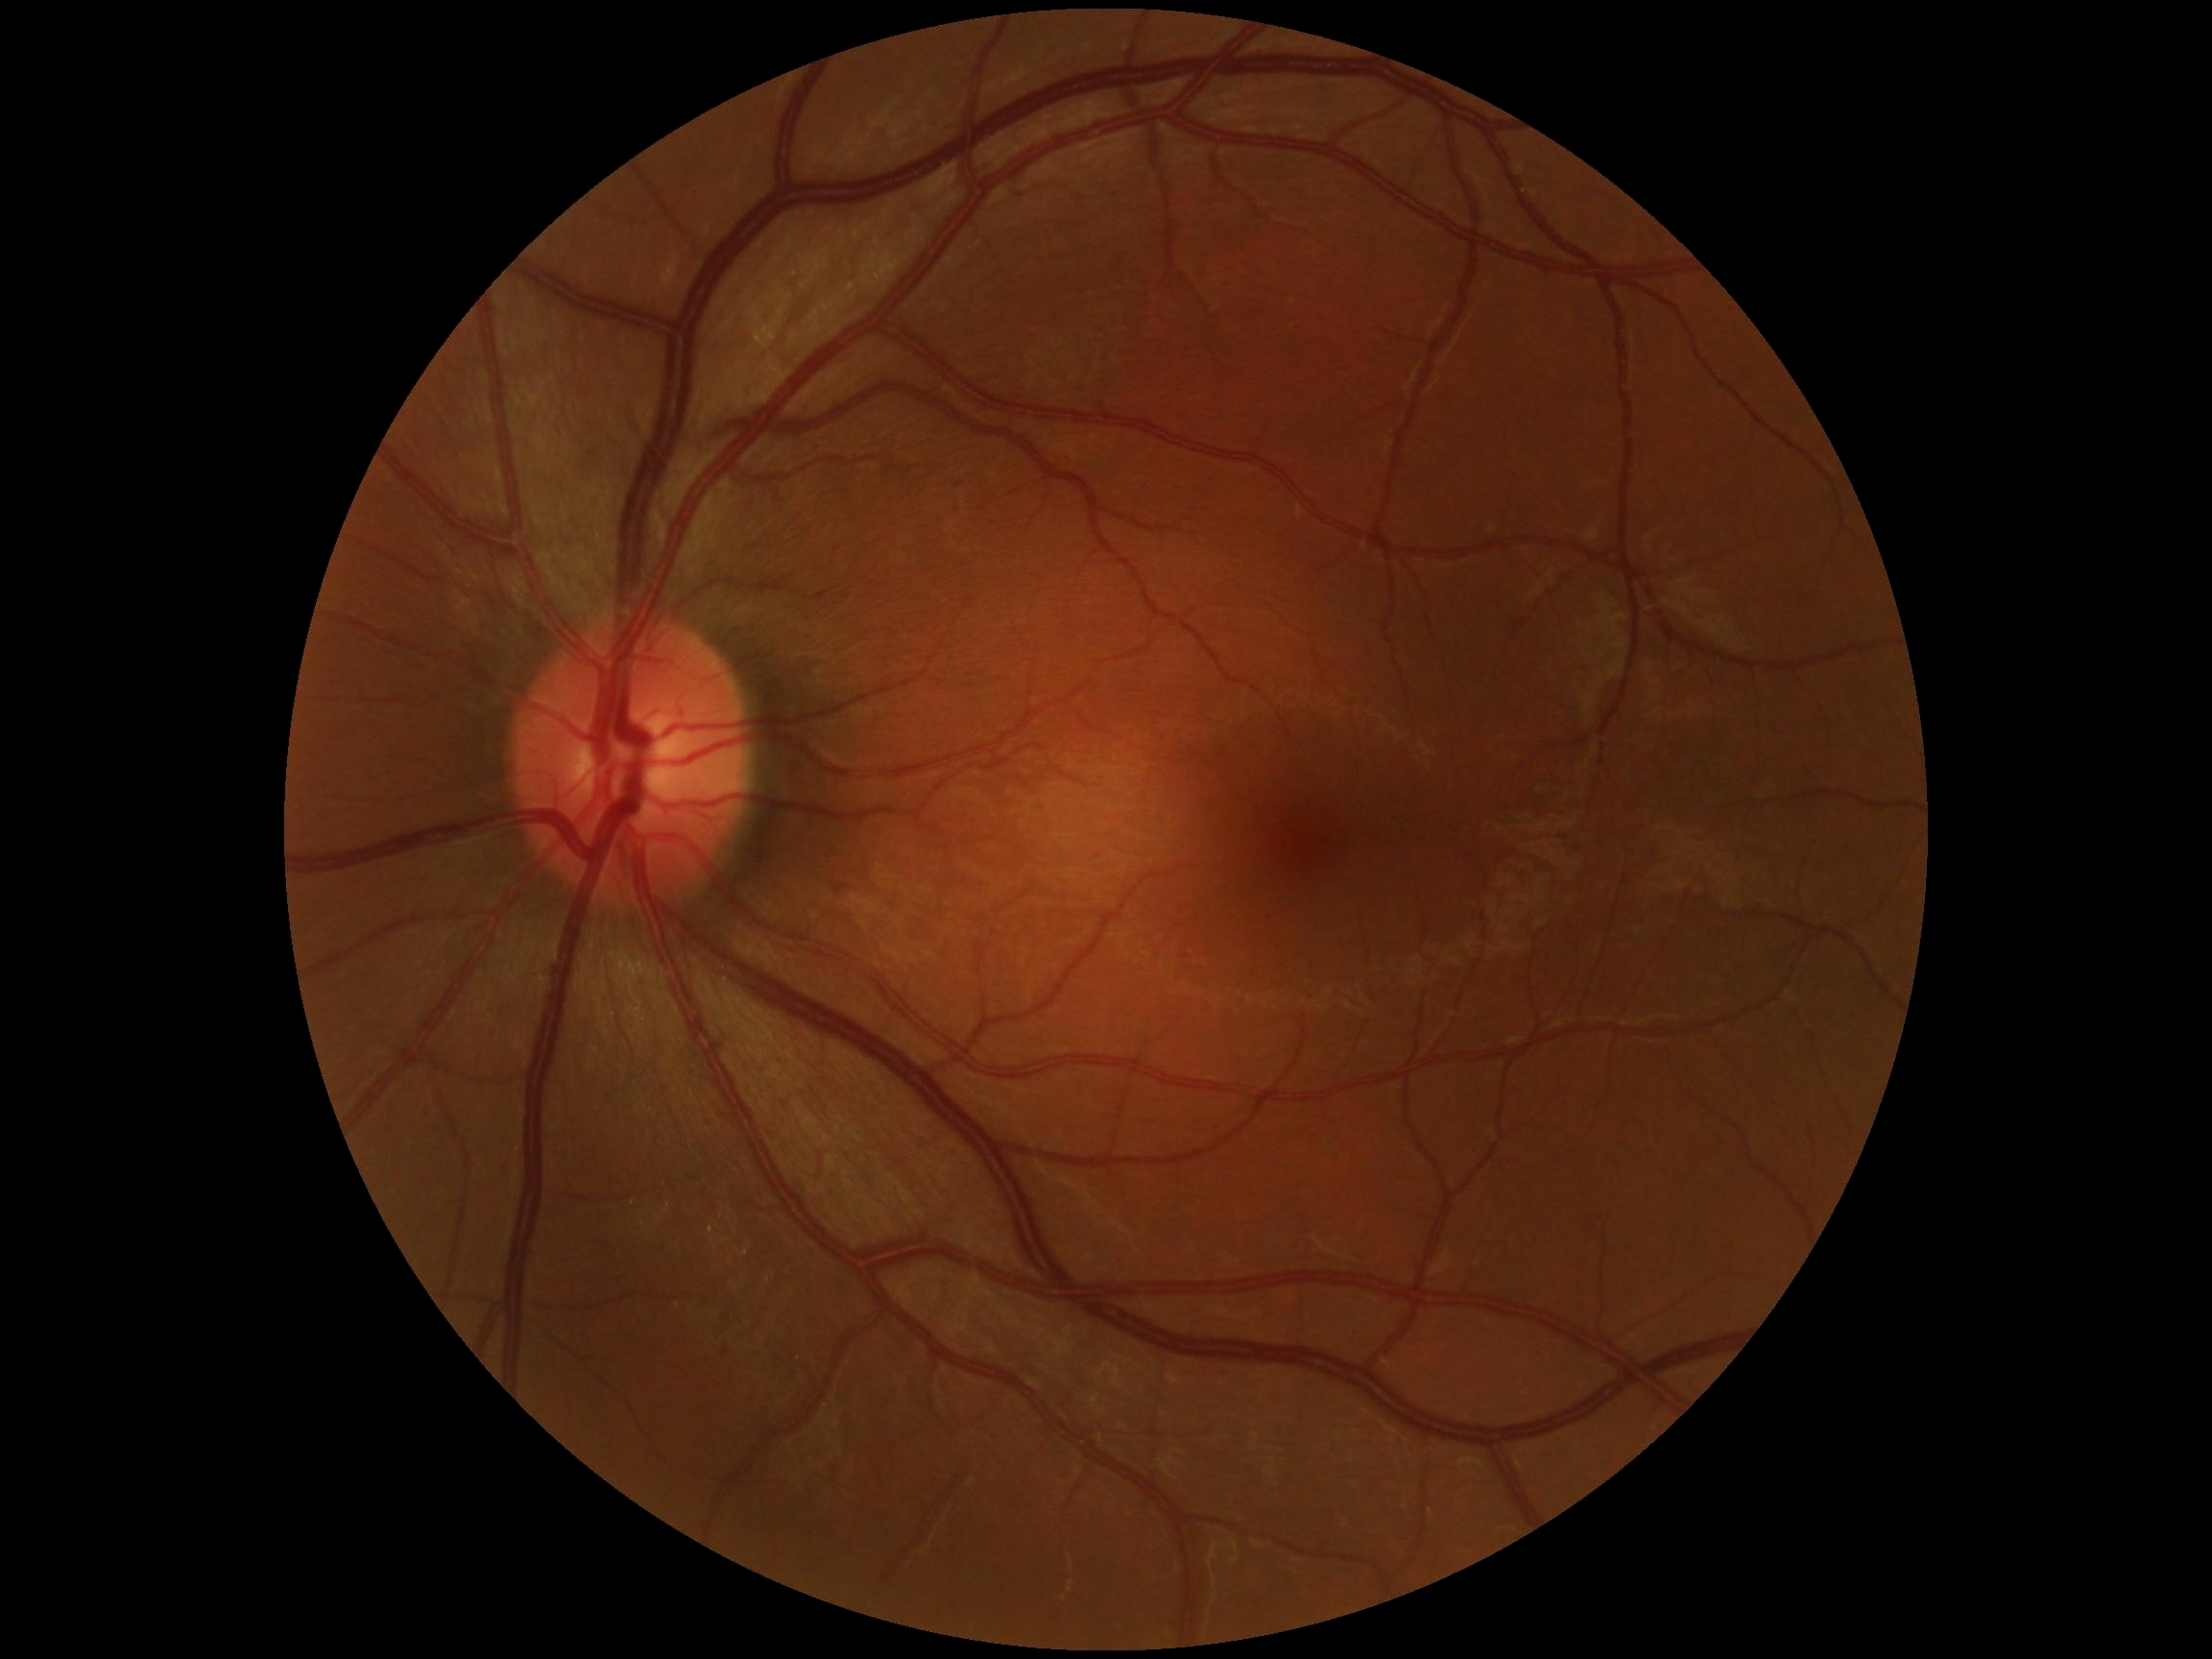 DR@no apparent retinopathy (grade 0) — no visible signs of diabetic retinopathy; DR impression@no apparent DR.